Color fundus photograph. Nonmydriatic. 848 by 848 pixels
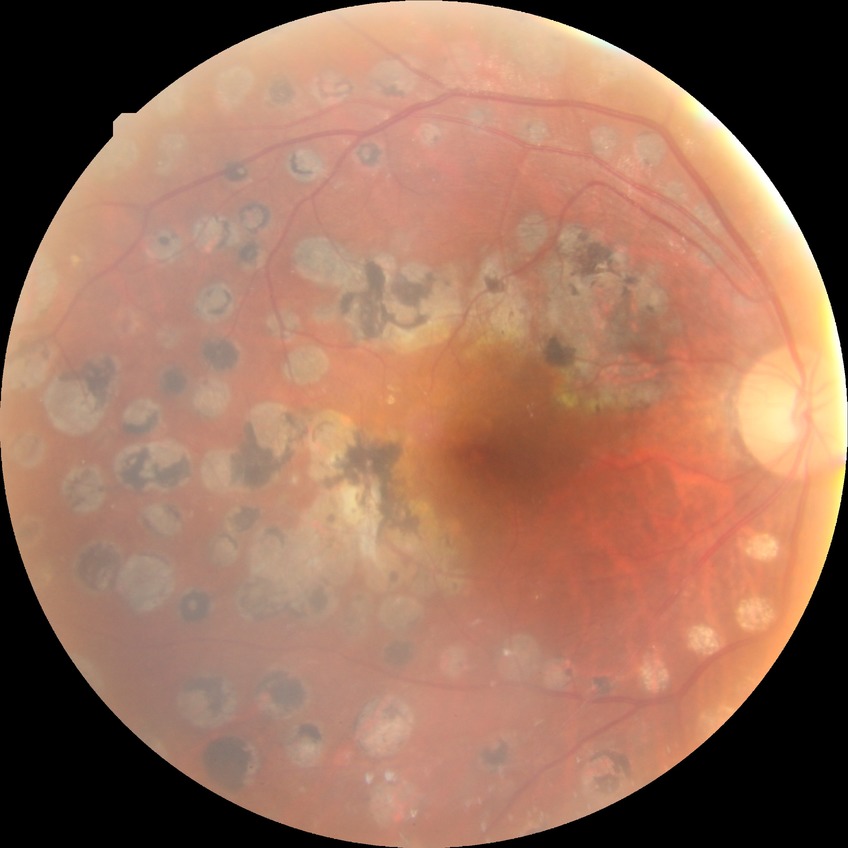

modified Davis grading: proliferative diabetic retinopathy